No pharmacologic dilation, graded on the modified Davis scale, color fundus photograph, NIDEK AFC-230 fundus camera.
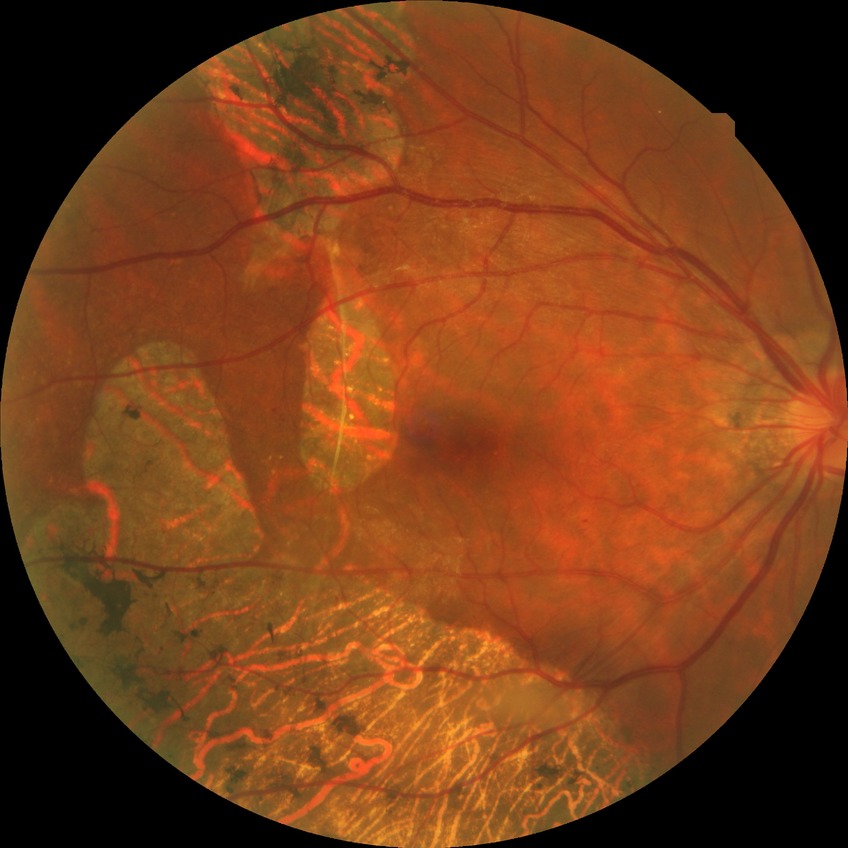

Diabetic retinopathy (DR) is SDR (simple diabetic retinopathy).